Wide-field contact fundus photograph of an infant — 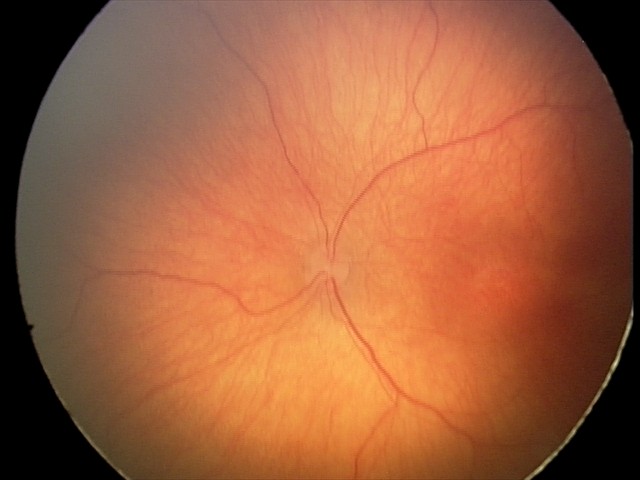

Without plus disease. From an examination with diagnosis of retinopathy of prematurity (ROP) stage 2.